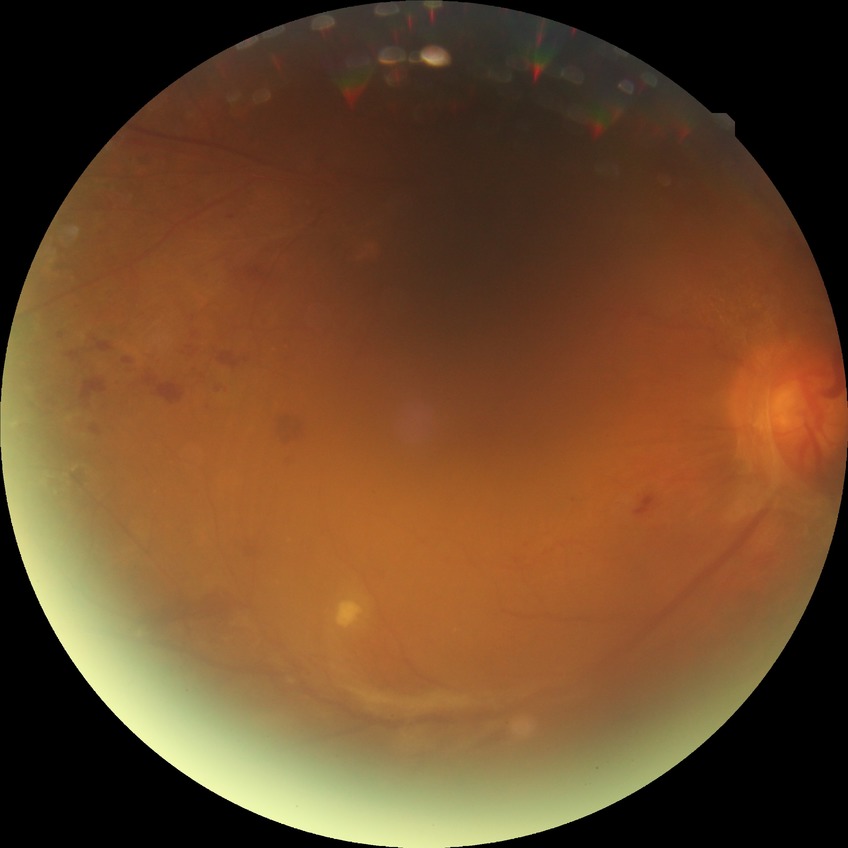 Assessment:
- diabetic retinopathy (DR): proliferative diabetic retinopathy (PDR)